Non-mydriatic fundus camera: 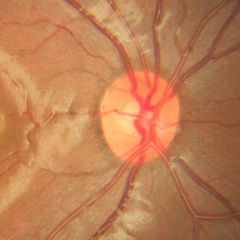
Optic disc appearance consistent with no glaucomatous changes.